Color fundus image. FOV: 45 degrees:
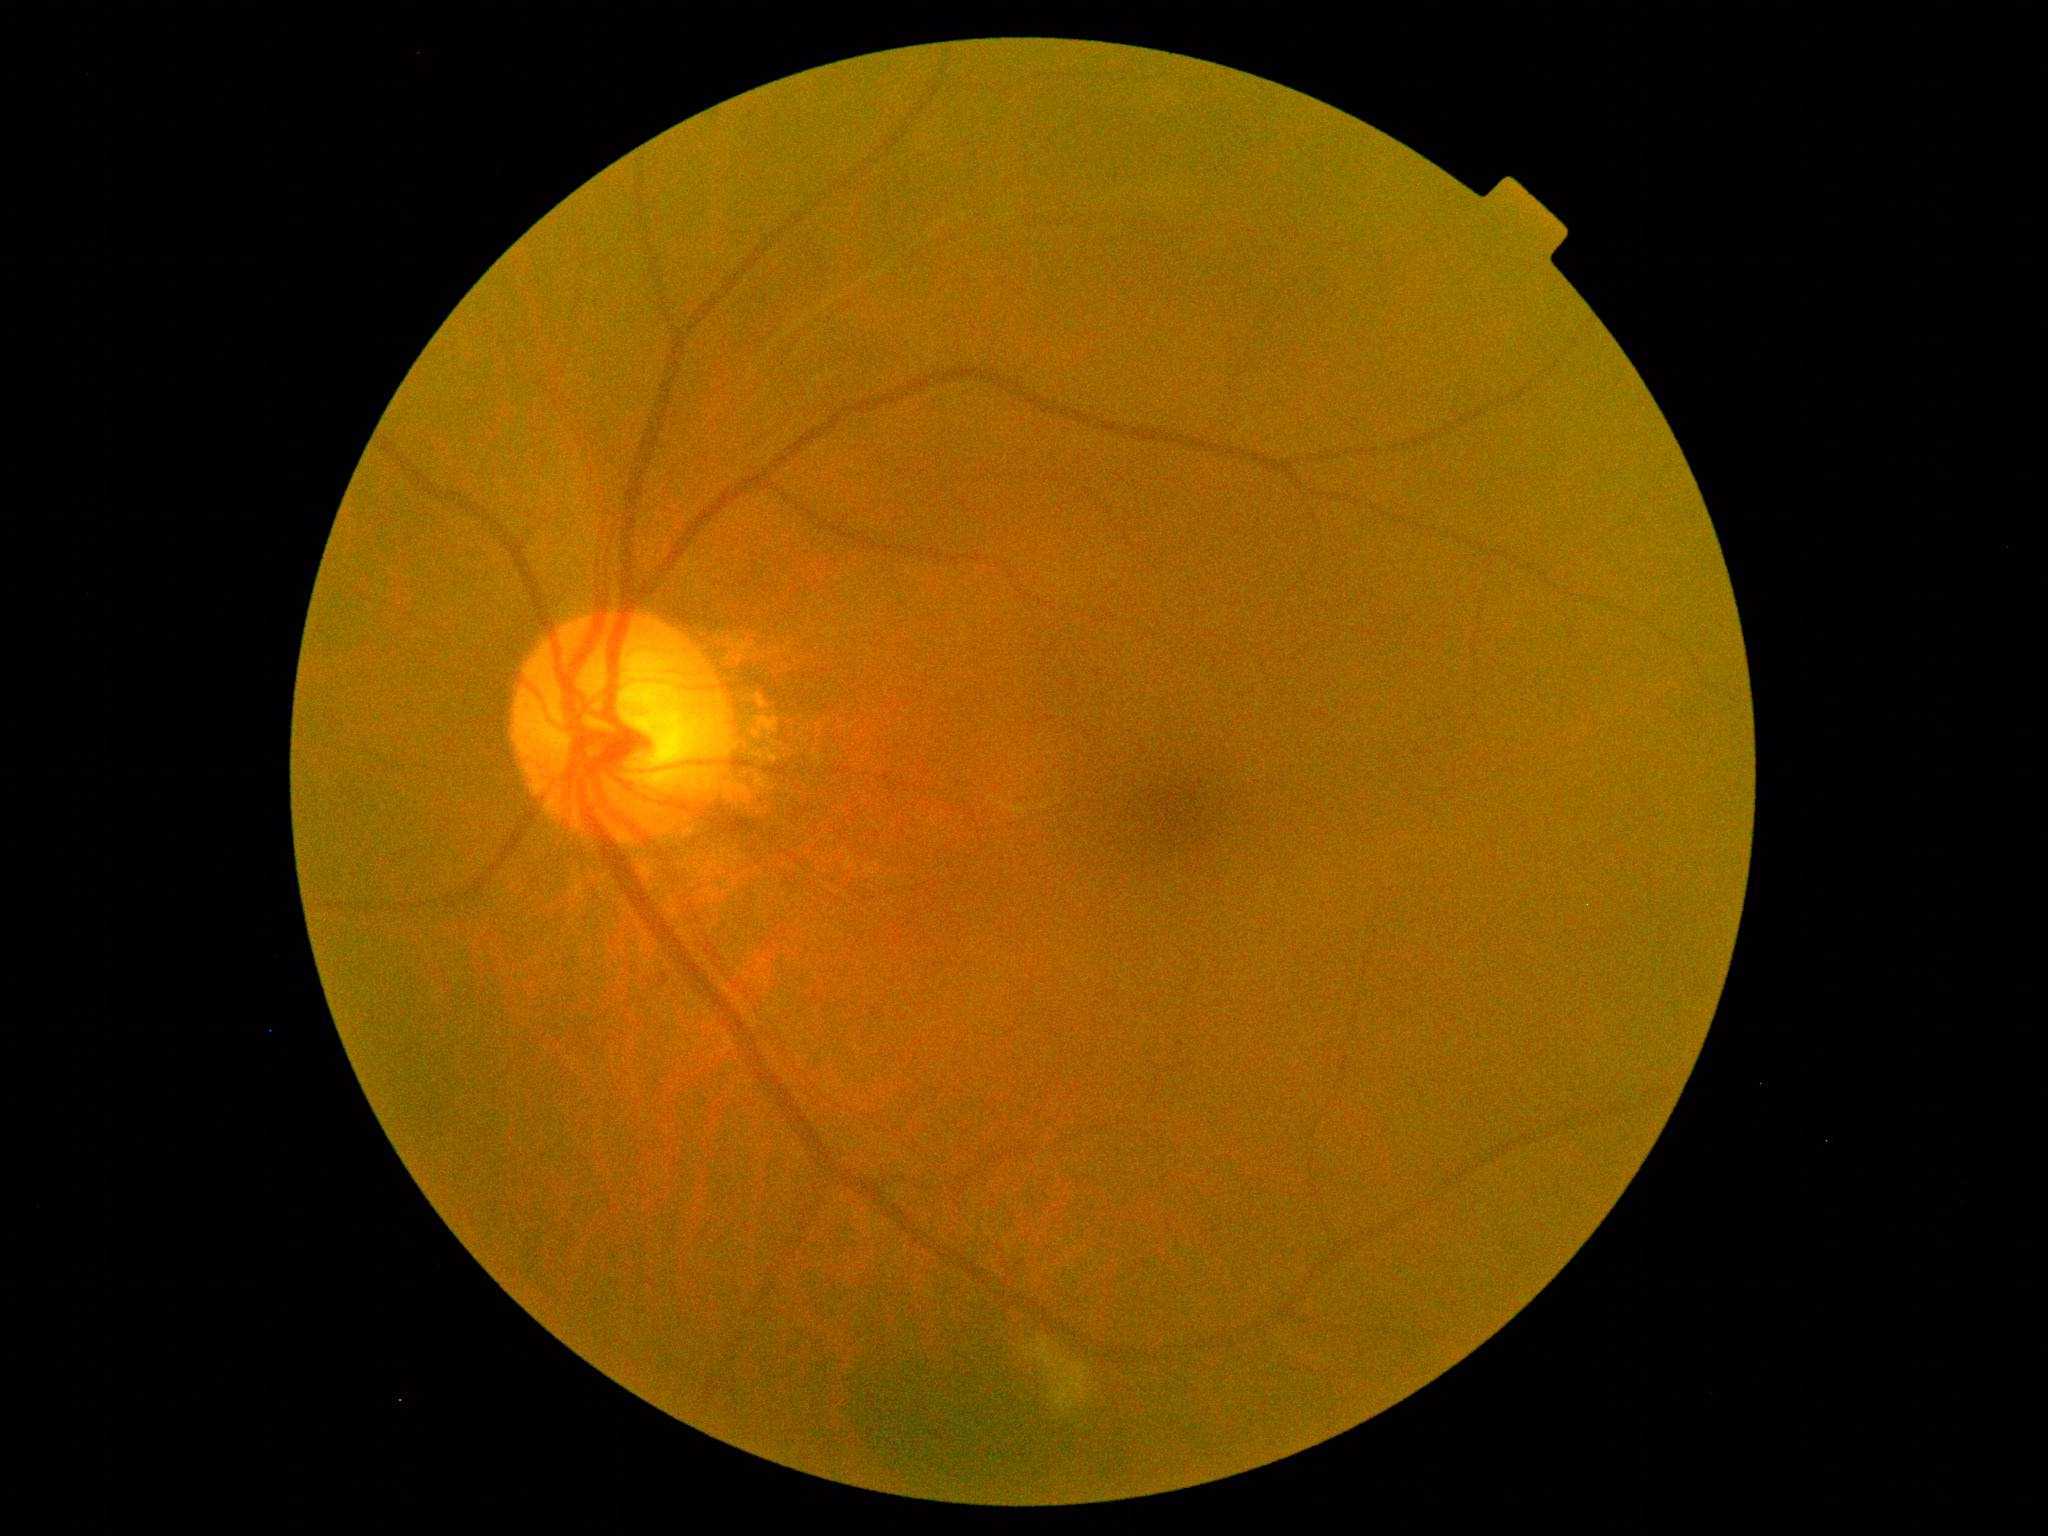

Diabetic retinopathy (DR): moderate NPDR (grade 2).